1240 by 1240 pixels; pediatric retinal photograph (wide-field)
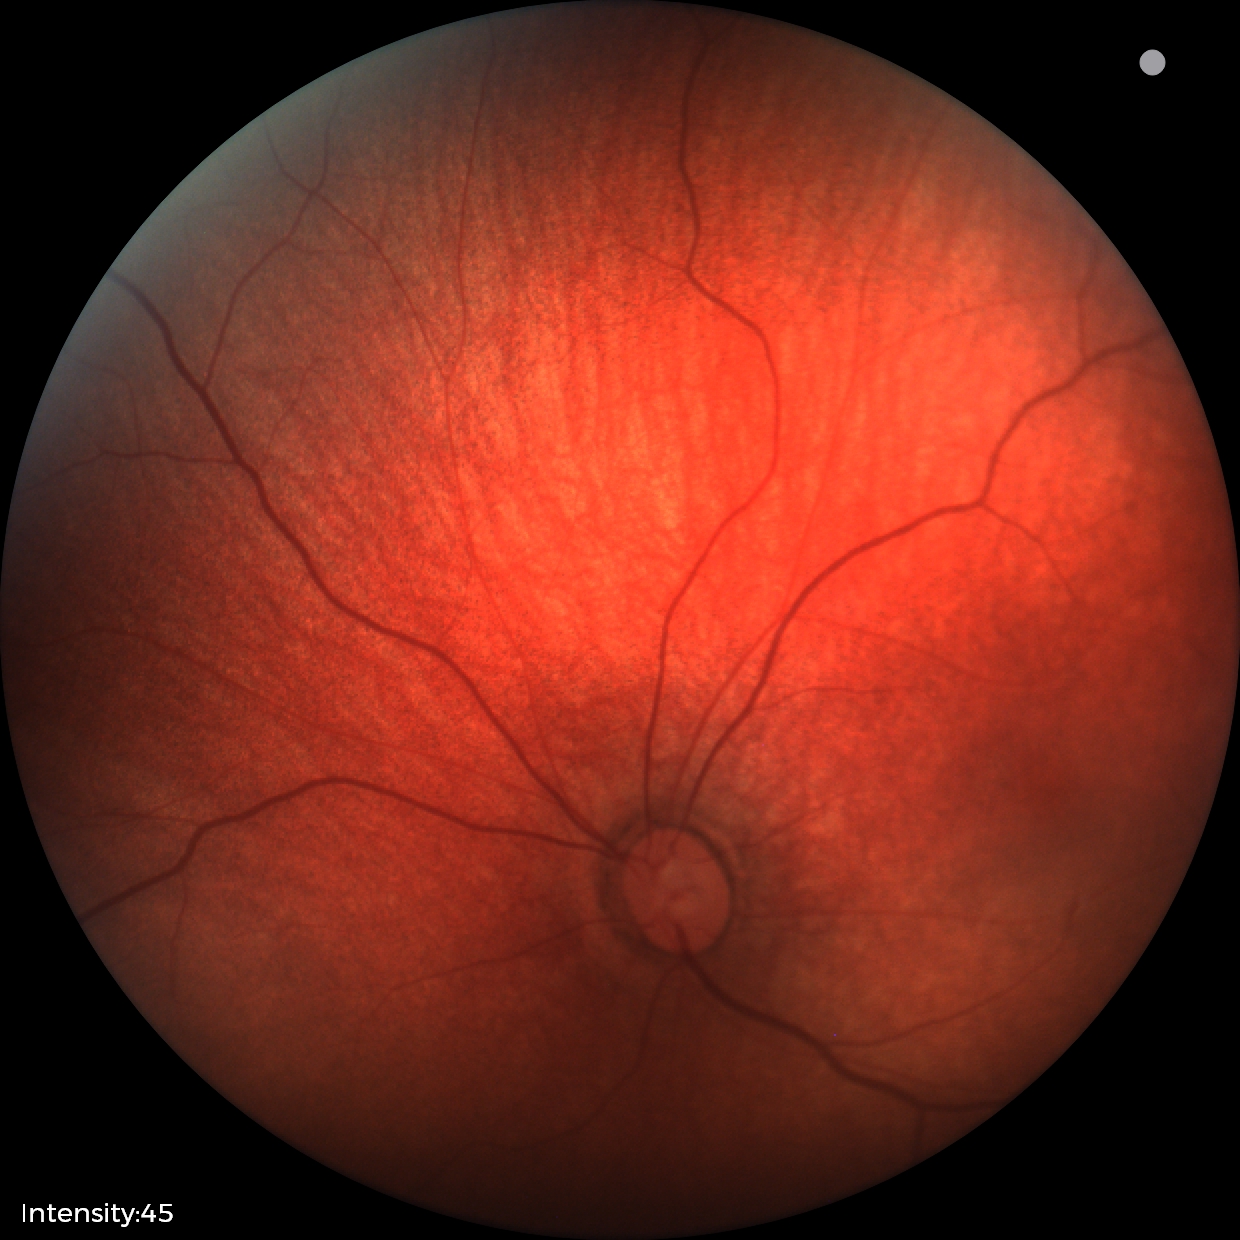 Normal screening examination.